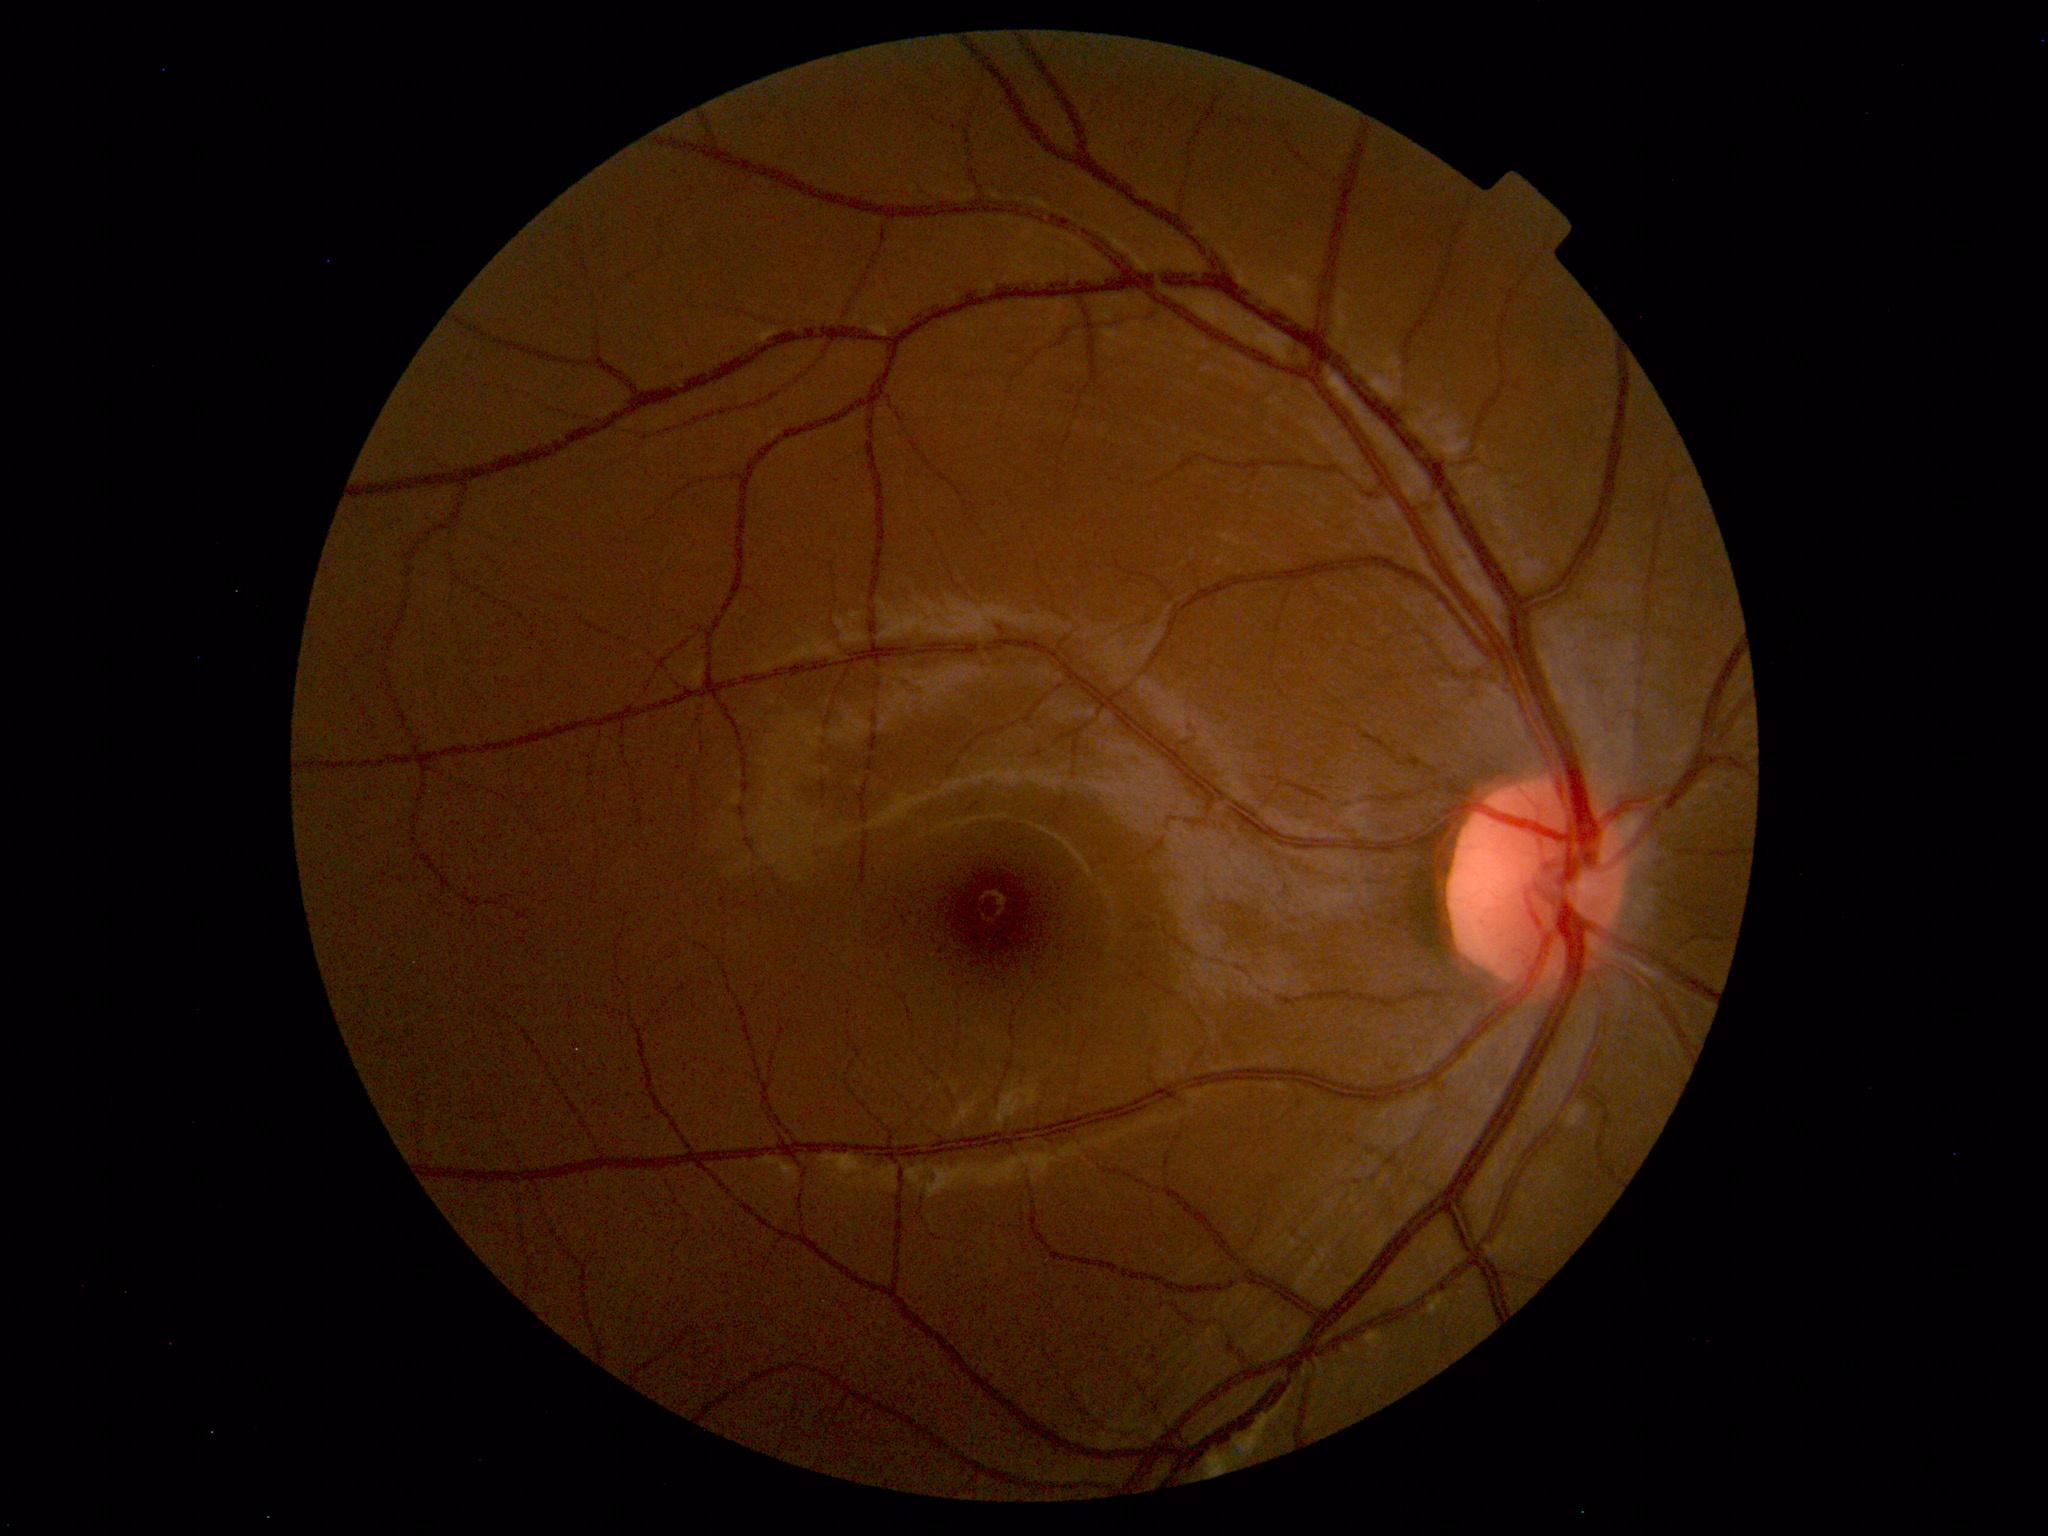 Impression: within normal limits.